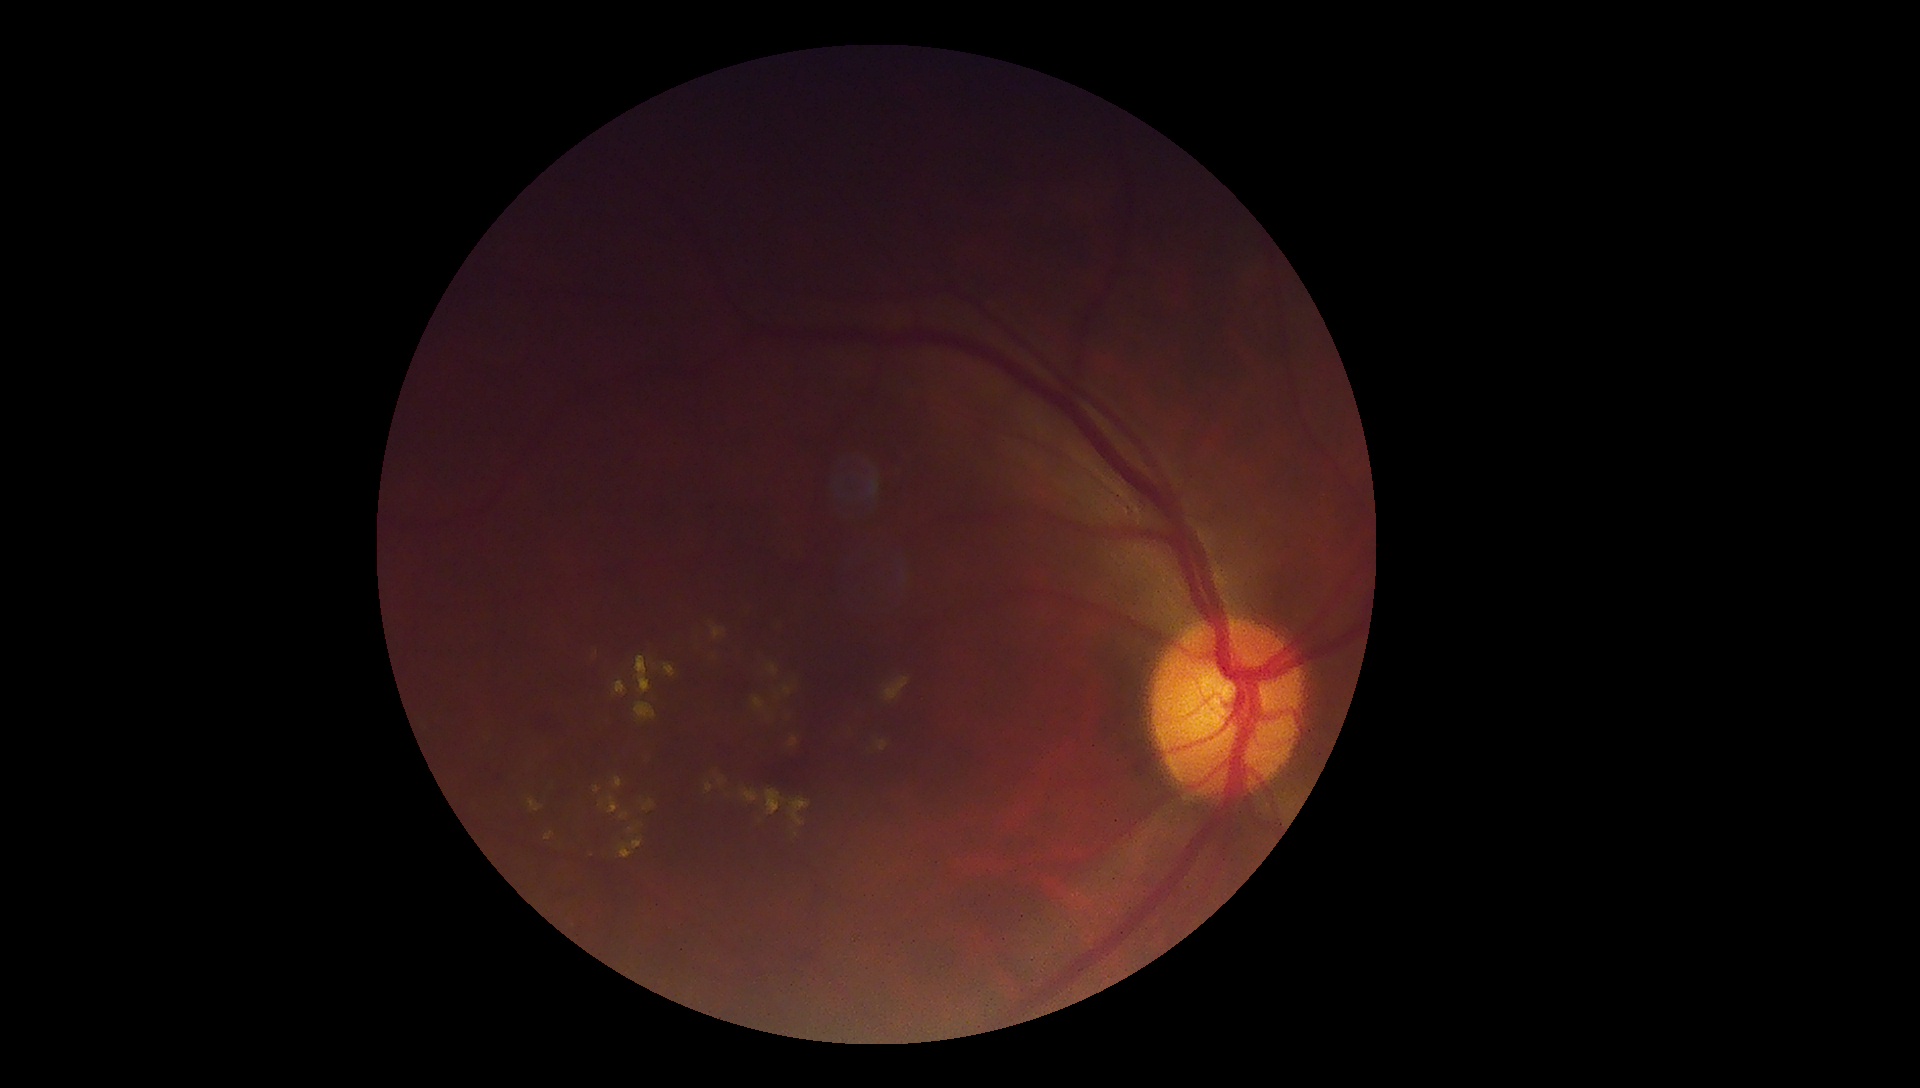
Annotations:
– diabetic retinopathy — 2
– DR class — non-proliferative diabetic retinopathy